45-degree field of view: 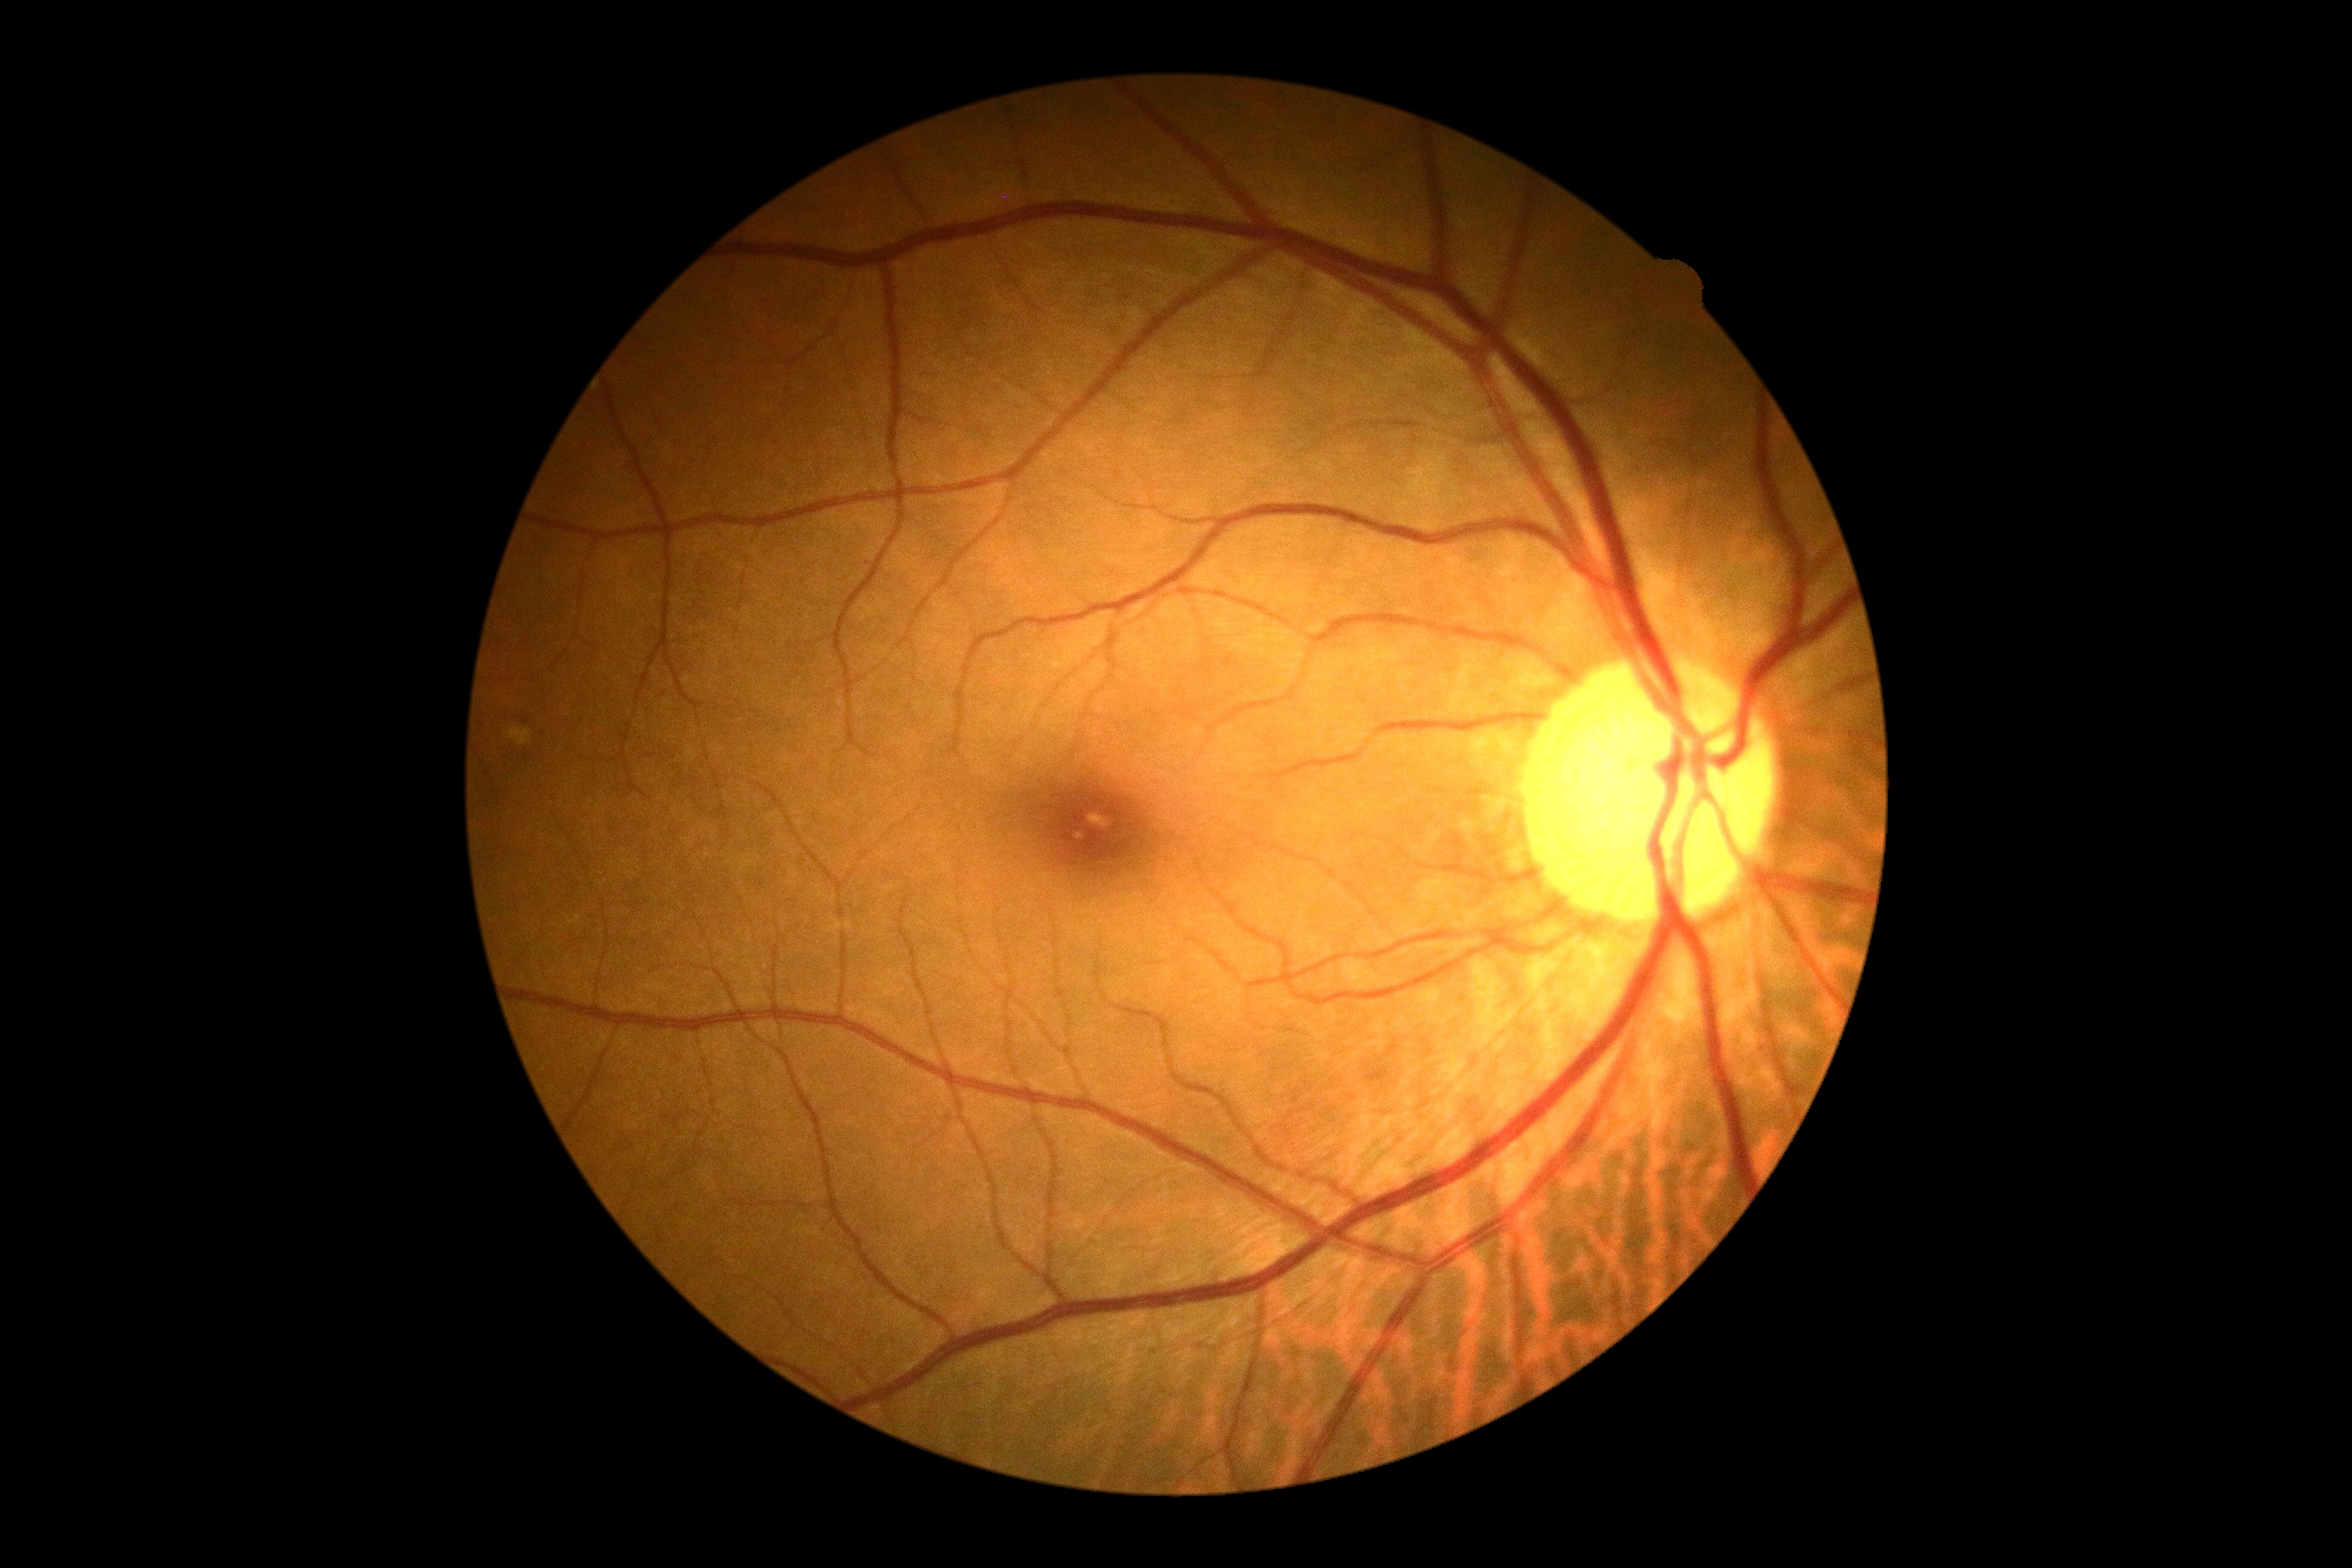

diabetic retinopathy: 0/4 — no visible signs of diabetic retinopathy.